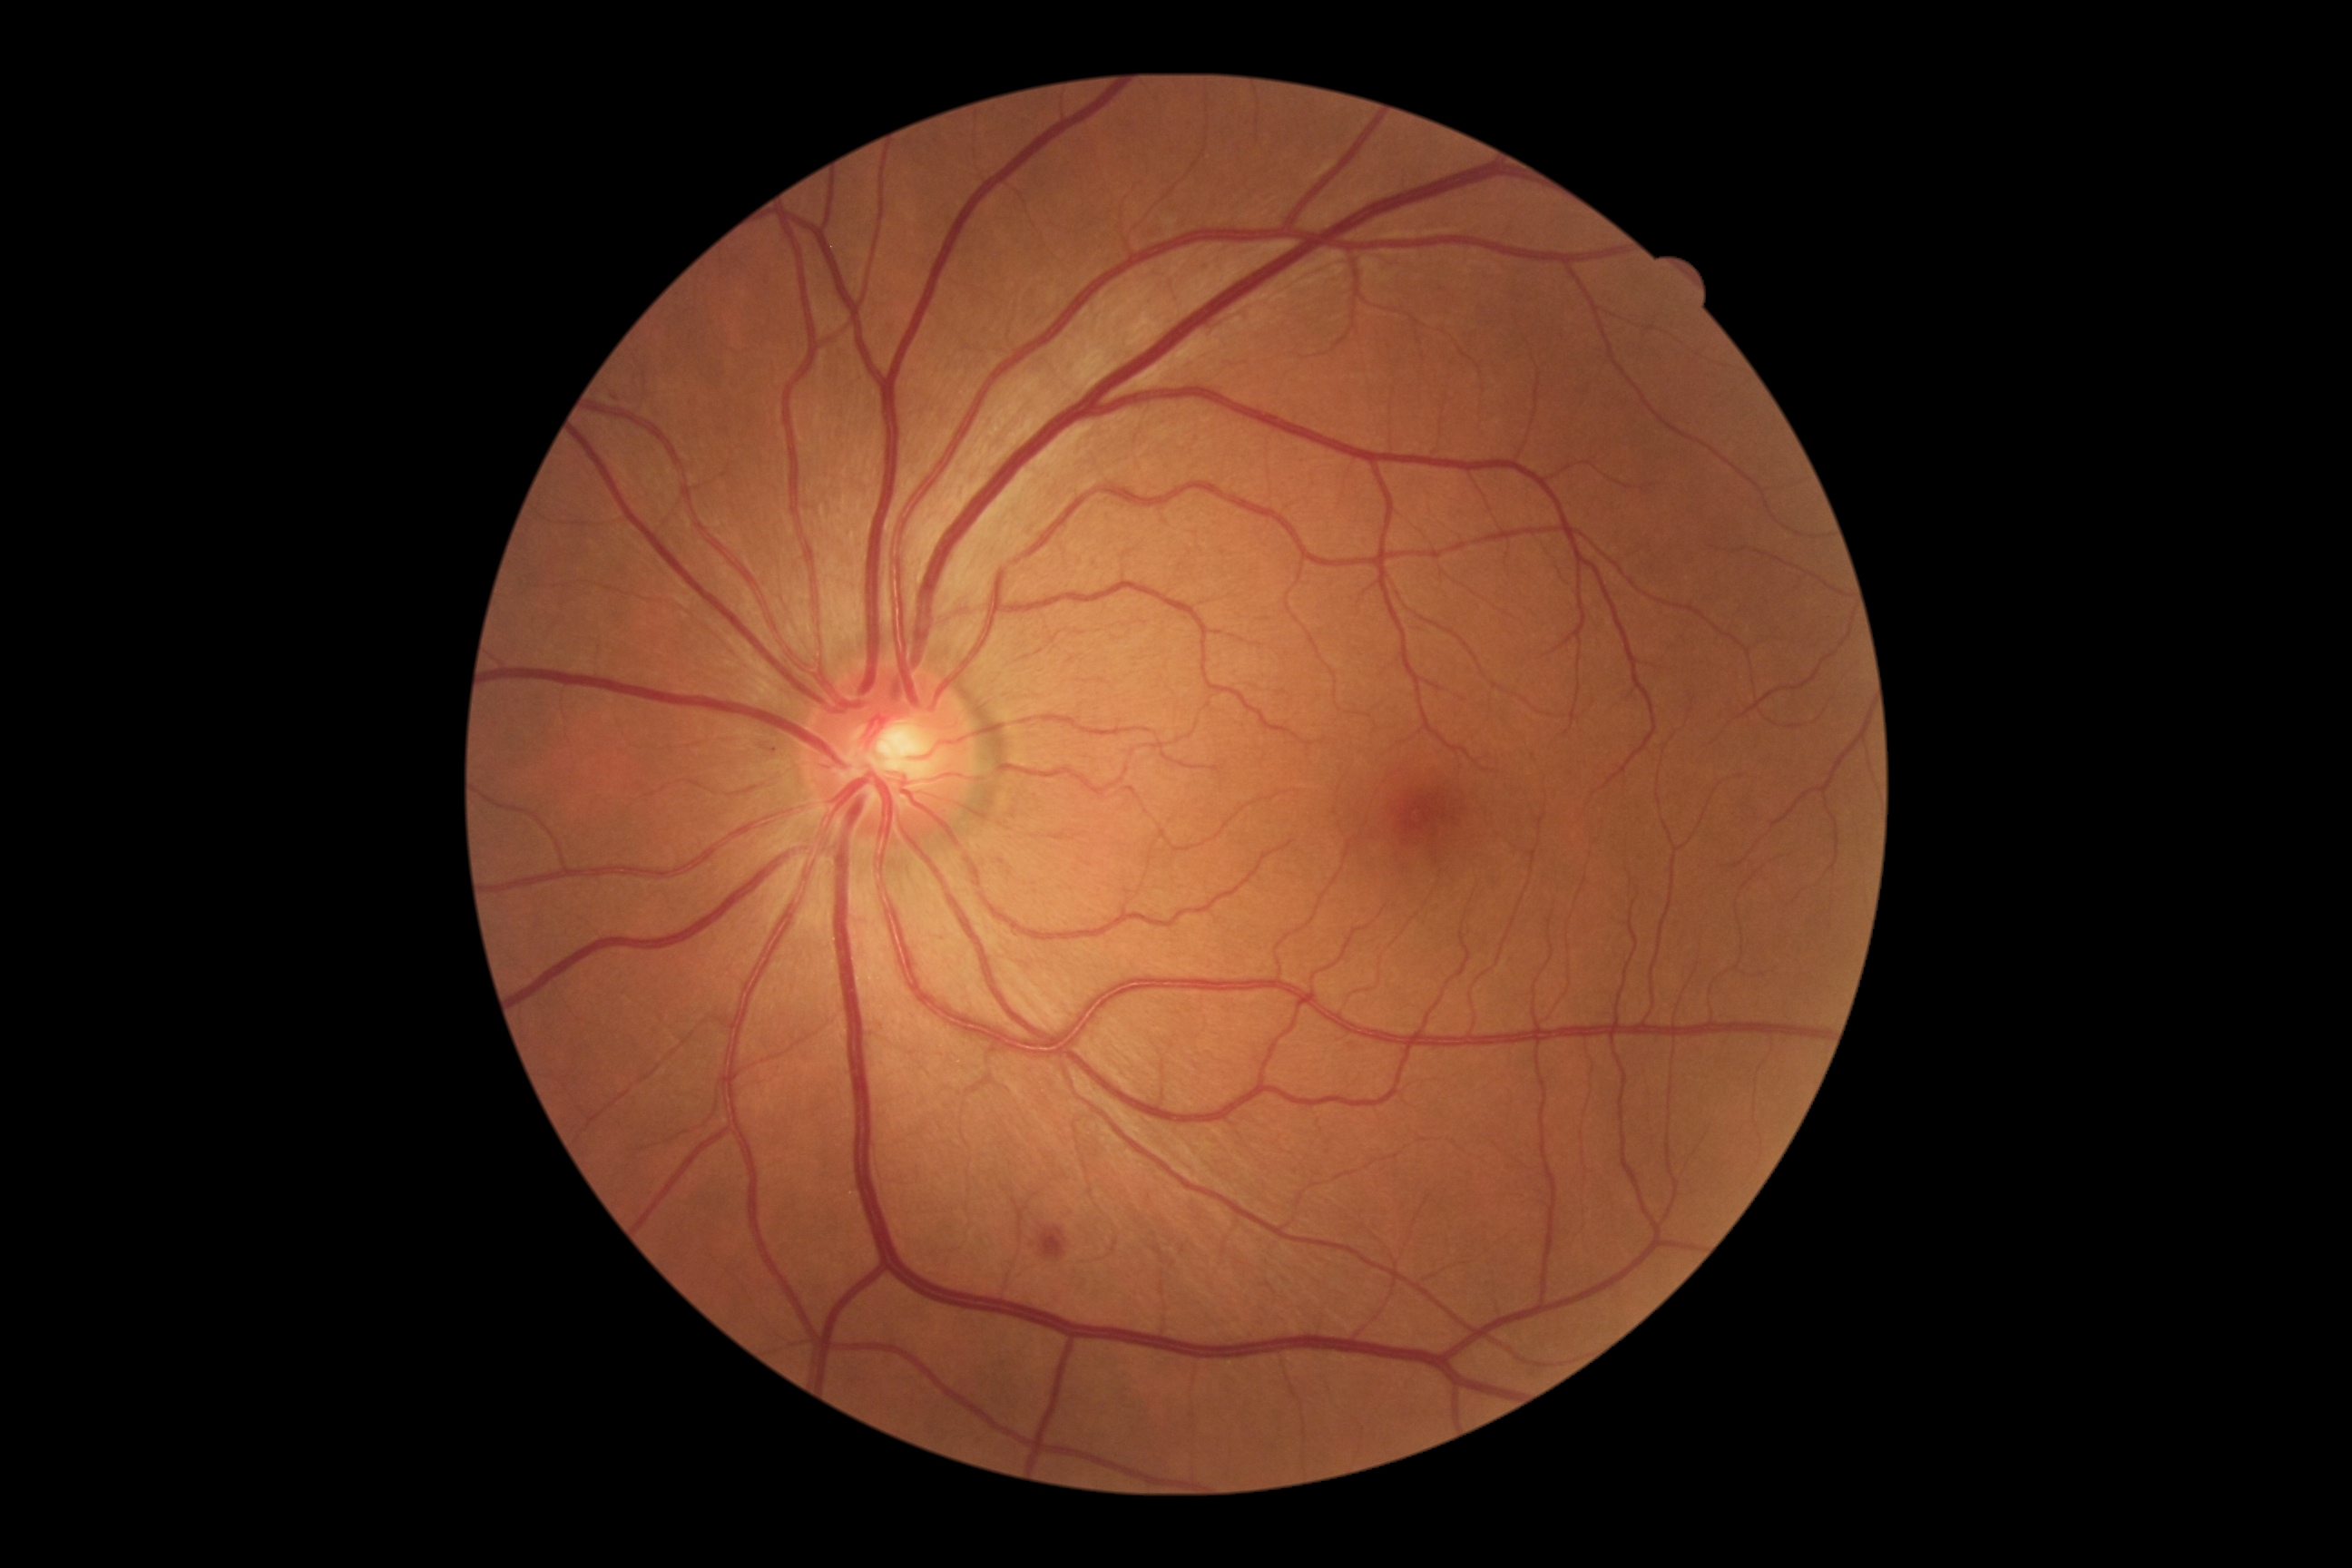

dr_grade: 2
dr_grade_name: moderate NPDR
lesions:
  ma_small_approx:
    - 1002/863
  ex: []
  he:
    - [left=1041, top=1228, right=1068, bottom=1260]
    - [left=758, top=741, right=787, bottom=760]
  se: []